Davis DR grading: 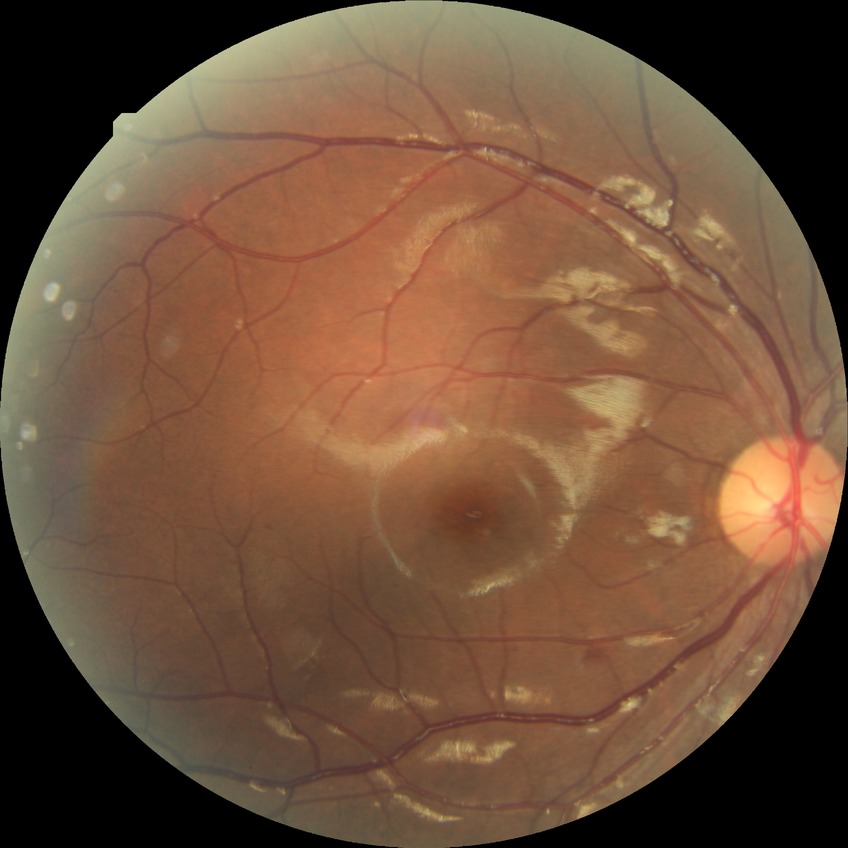
Modified Davis classification is simple diabetic retinopathy.